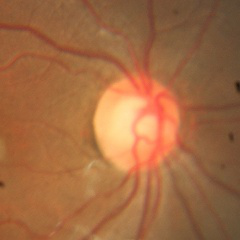 Glaucoma status = no evidence of glaucoma.